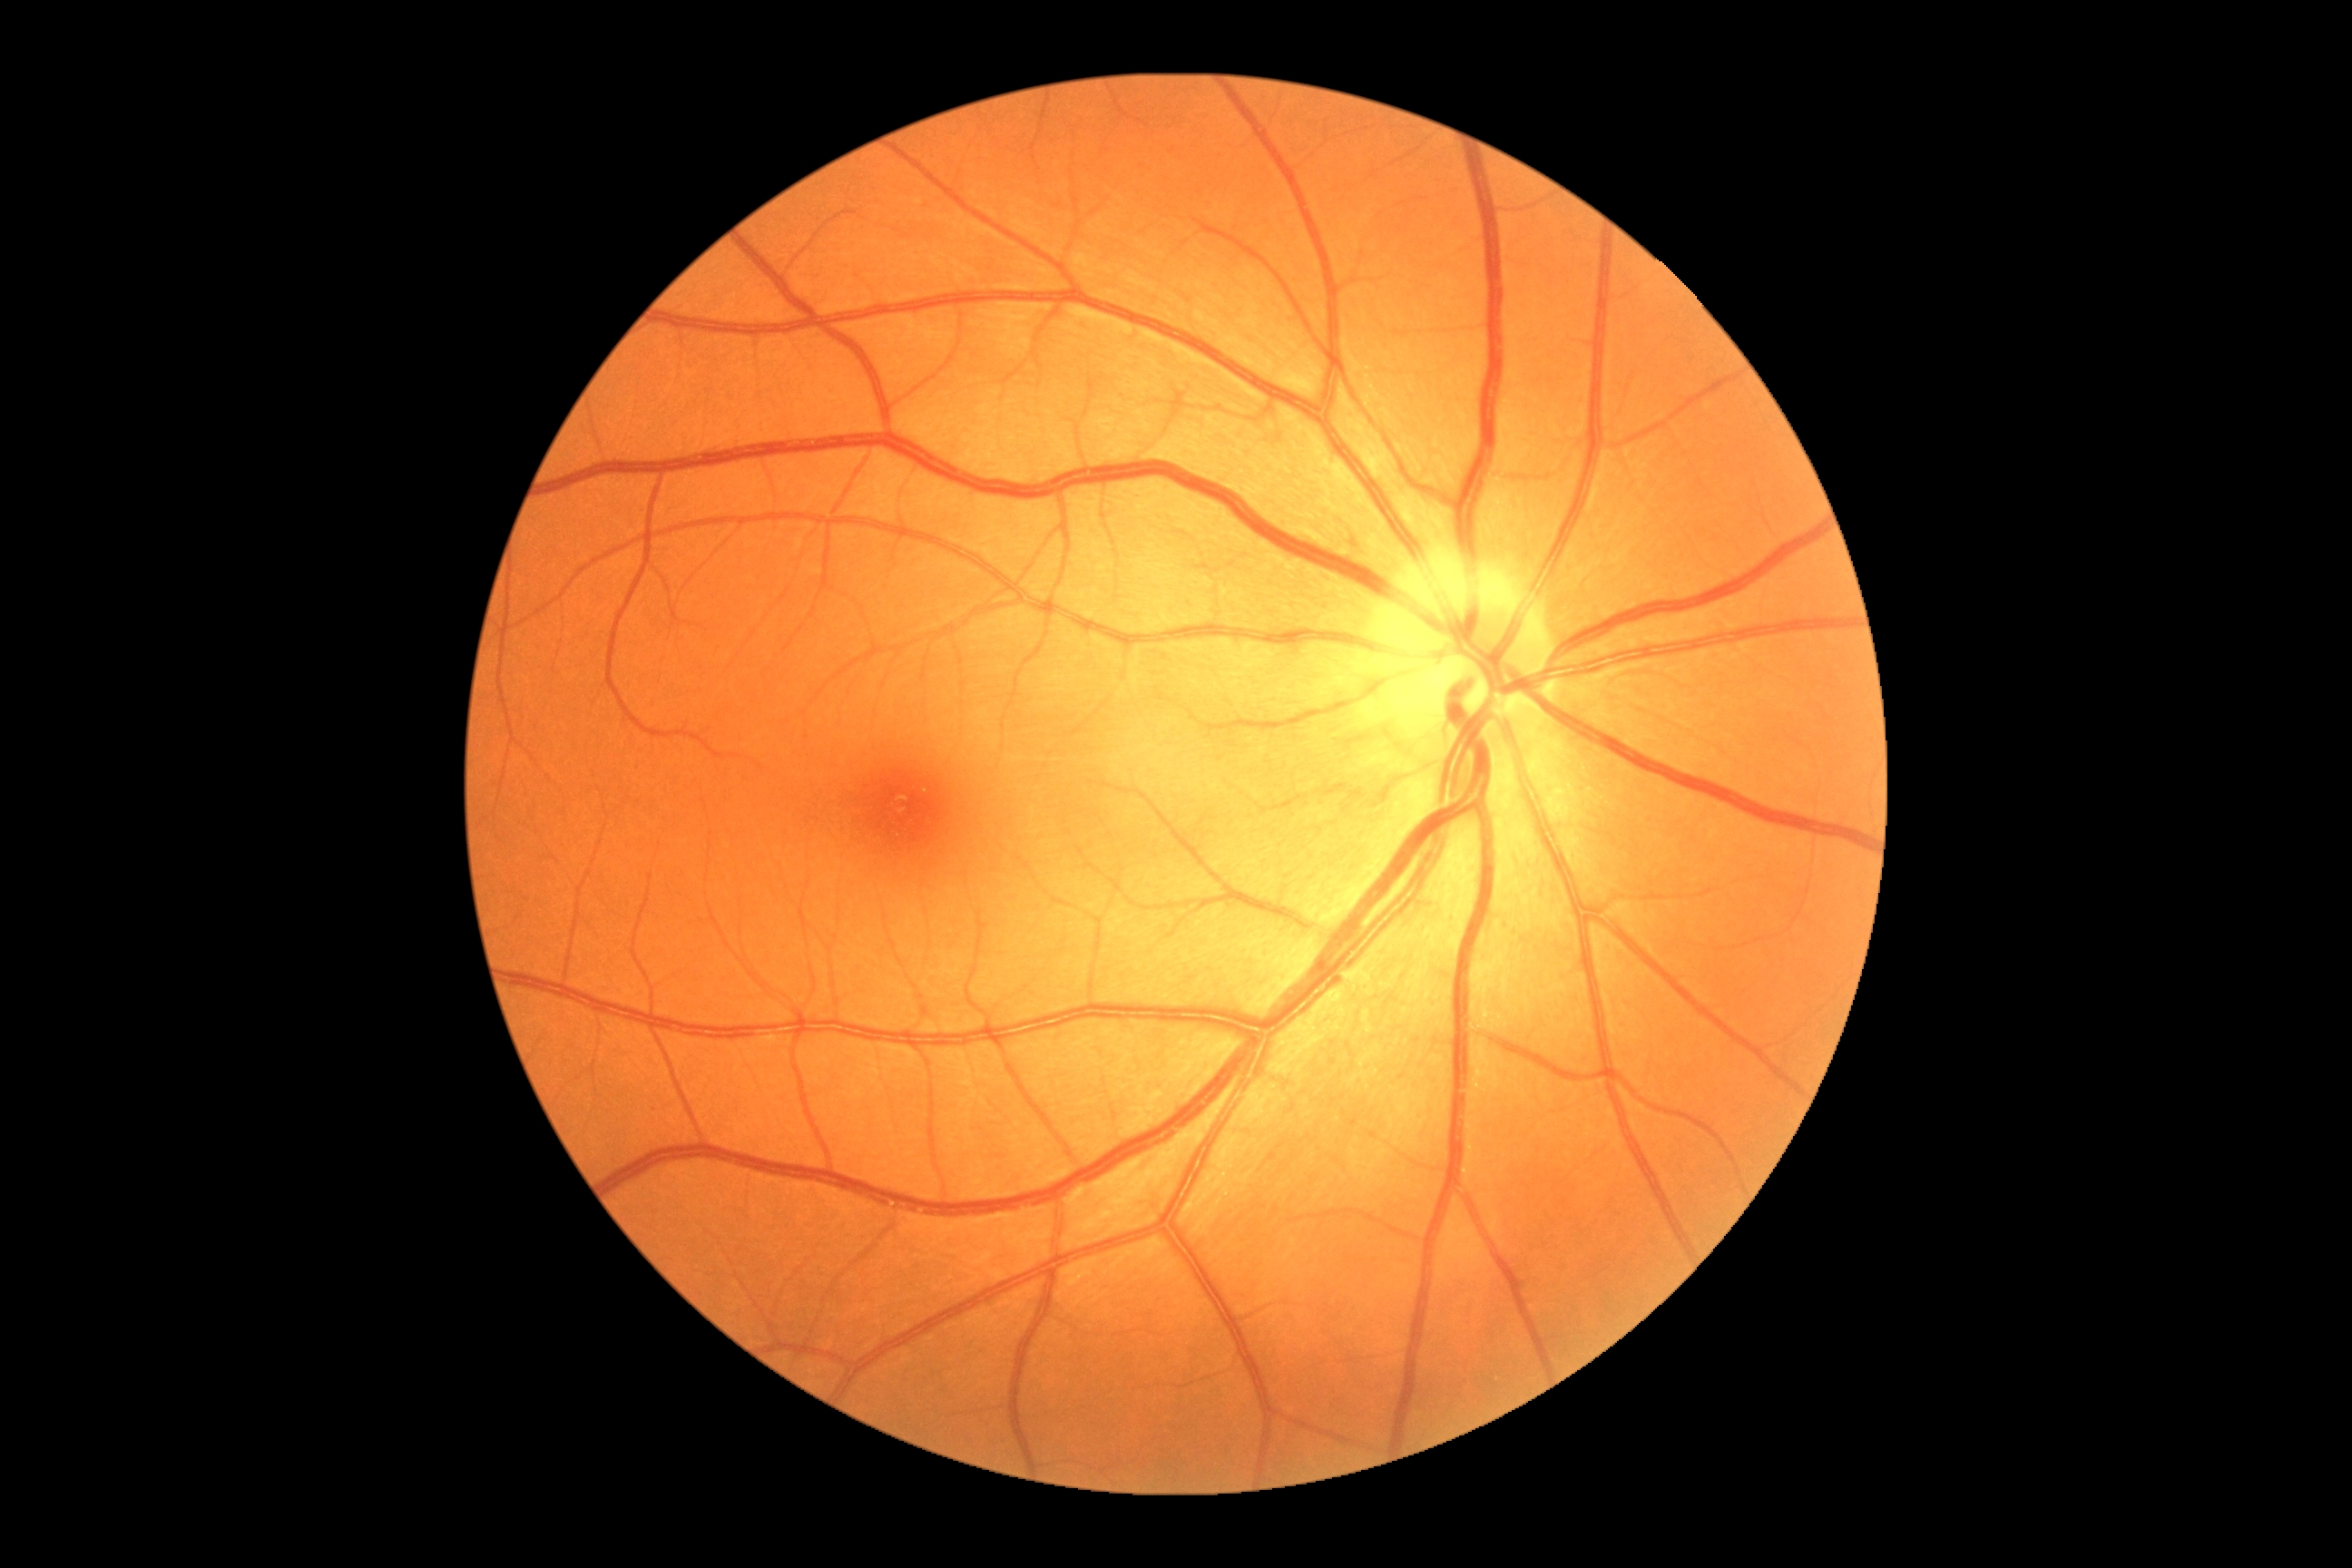
DR impression = no apparent DR; diabetic retinopathy = grade 0.